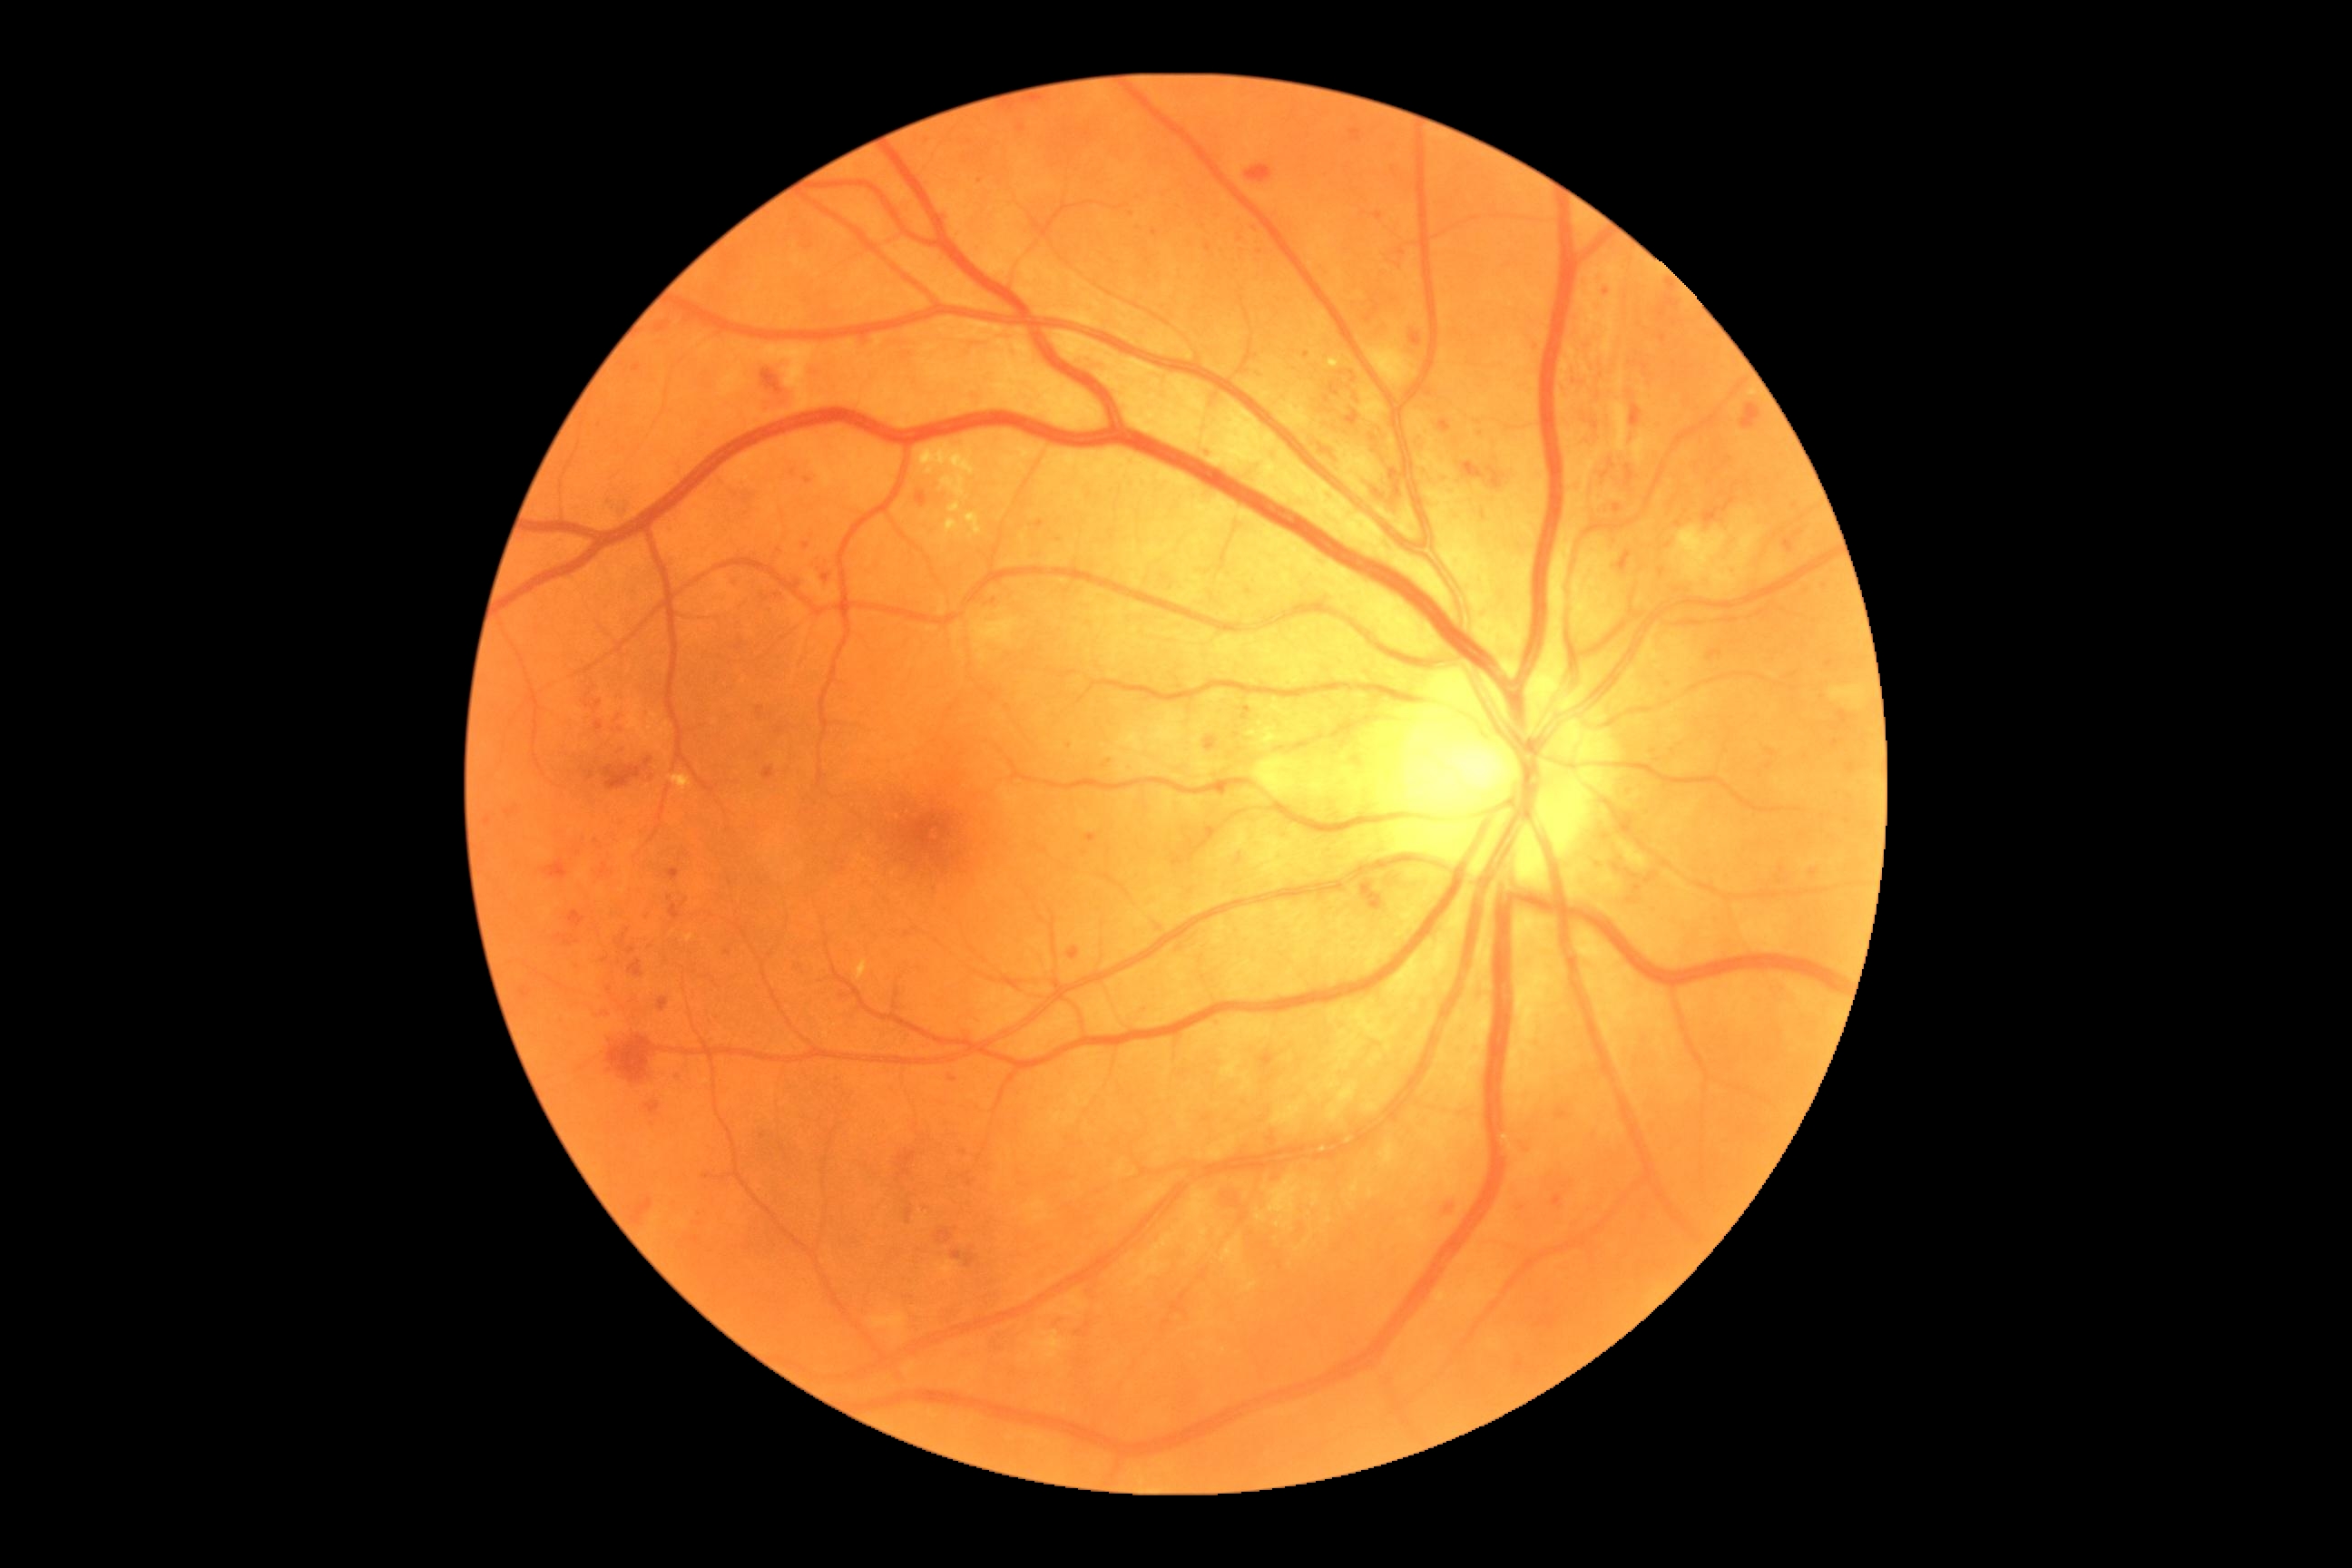

{"partial": true, "dr_grade": 3, "dr_grade_name": "severe NPDR", "lesions": {"he": [[1057, 1311, 1070, 1320], [647, 1101, 660, 1115], [544, 861, 569, 879], [1371, 440, 1402, 498], [1516, 1199, 1527, 1210], [1703, 498, 1736, 525], [1329, 384, 1340, 397], [1627, 429, 1638, 446], [1509, 1357, 1525, 1375], [520, 988, 531, 999], [1438, 420, 1451, 433], [1315, 440, 1342, 460], [602, 500, 611, 509], [505, 808, 516, 816], [1068, 946, 1079, 961], [629, 959, 643, 977], [730, 578, 740, 585], [1625, 466, 1634, 485], [1346, 411, 1360, 426]], "he_small_approx": [[1799, 533]], "ma": [[596, 700, 602, 709], [643, 910, 651, 917], [1086, 834, 1097, 843], [1605, 289, 1611, 297], [692, 1237, 700, 1244], [1035, 520, 1044, 529]], "ma_small_approx": [[808, 481], [763, 1136], [1088, 1326], [596, 841], [994, 601], [1139, 227], [1403, 252], [1057, 538], [1835, 744], [1255, 356], [1669, 547], [1248, 710]]}}